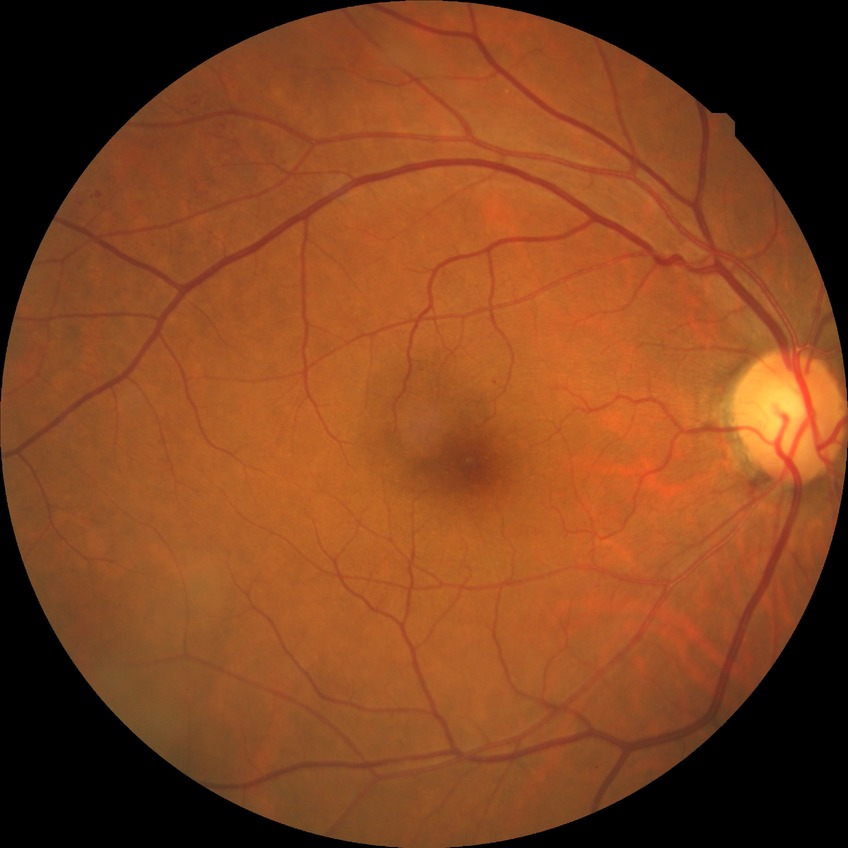

Diabetic retinopathy grade: simple diabetic retinopathy.